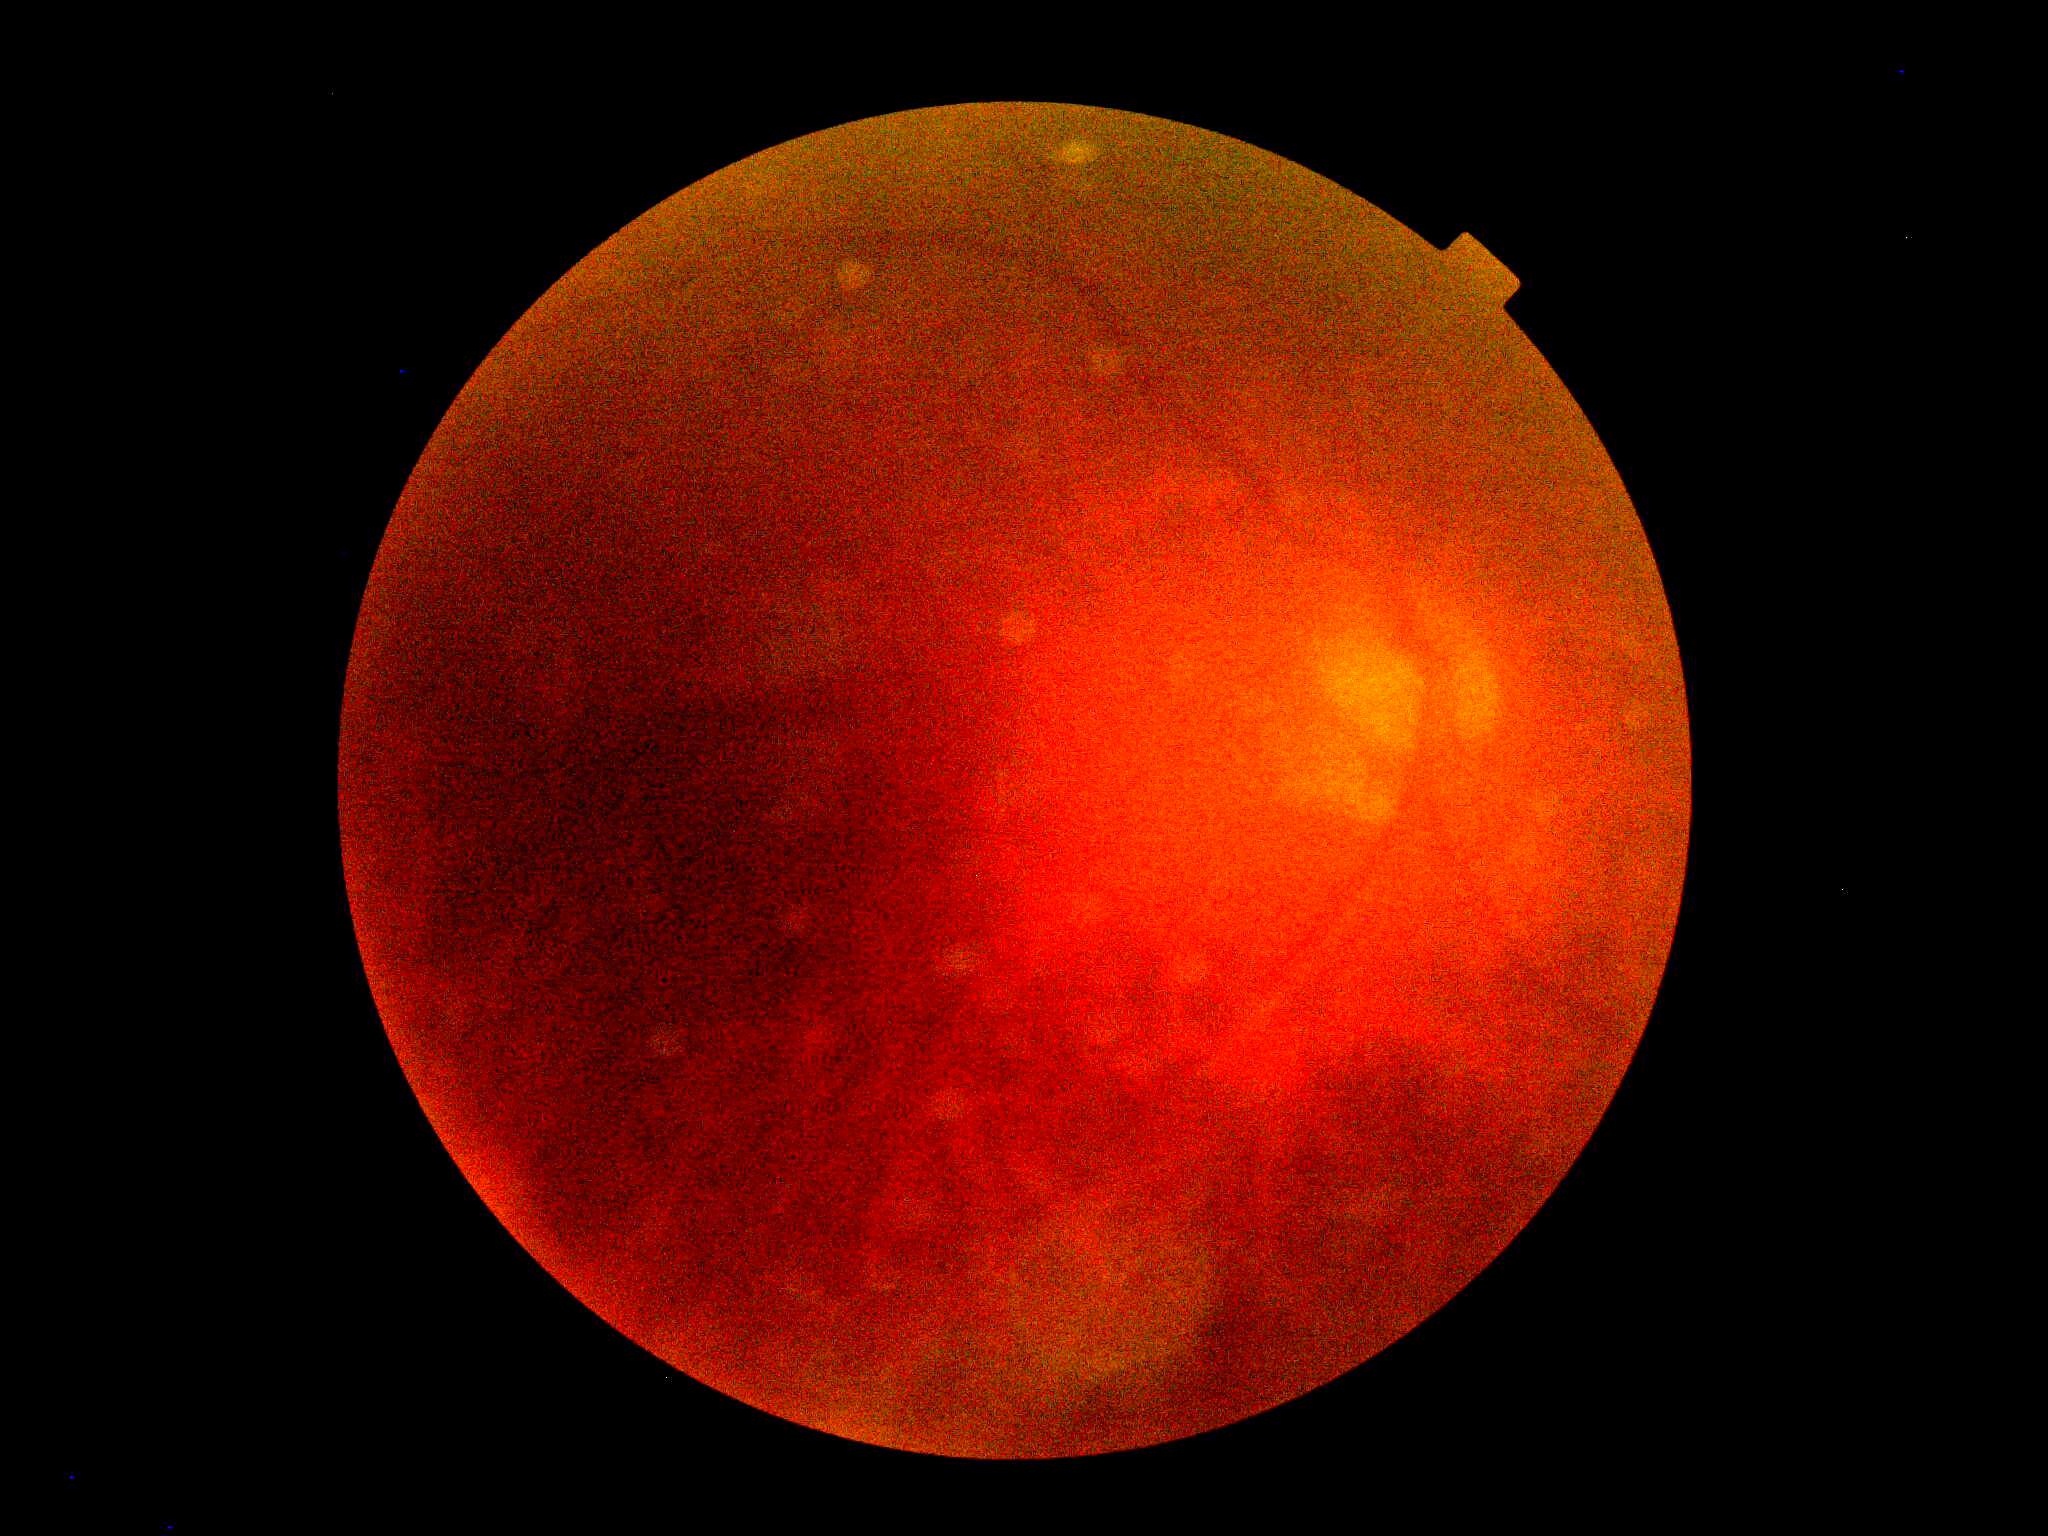
Findings:
• DR severity — ungradable due to poor image quality